50° FOV, pupil-dilated:
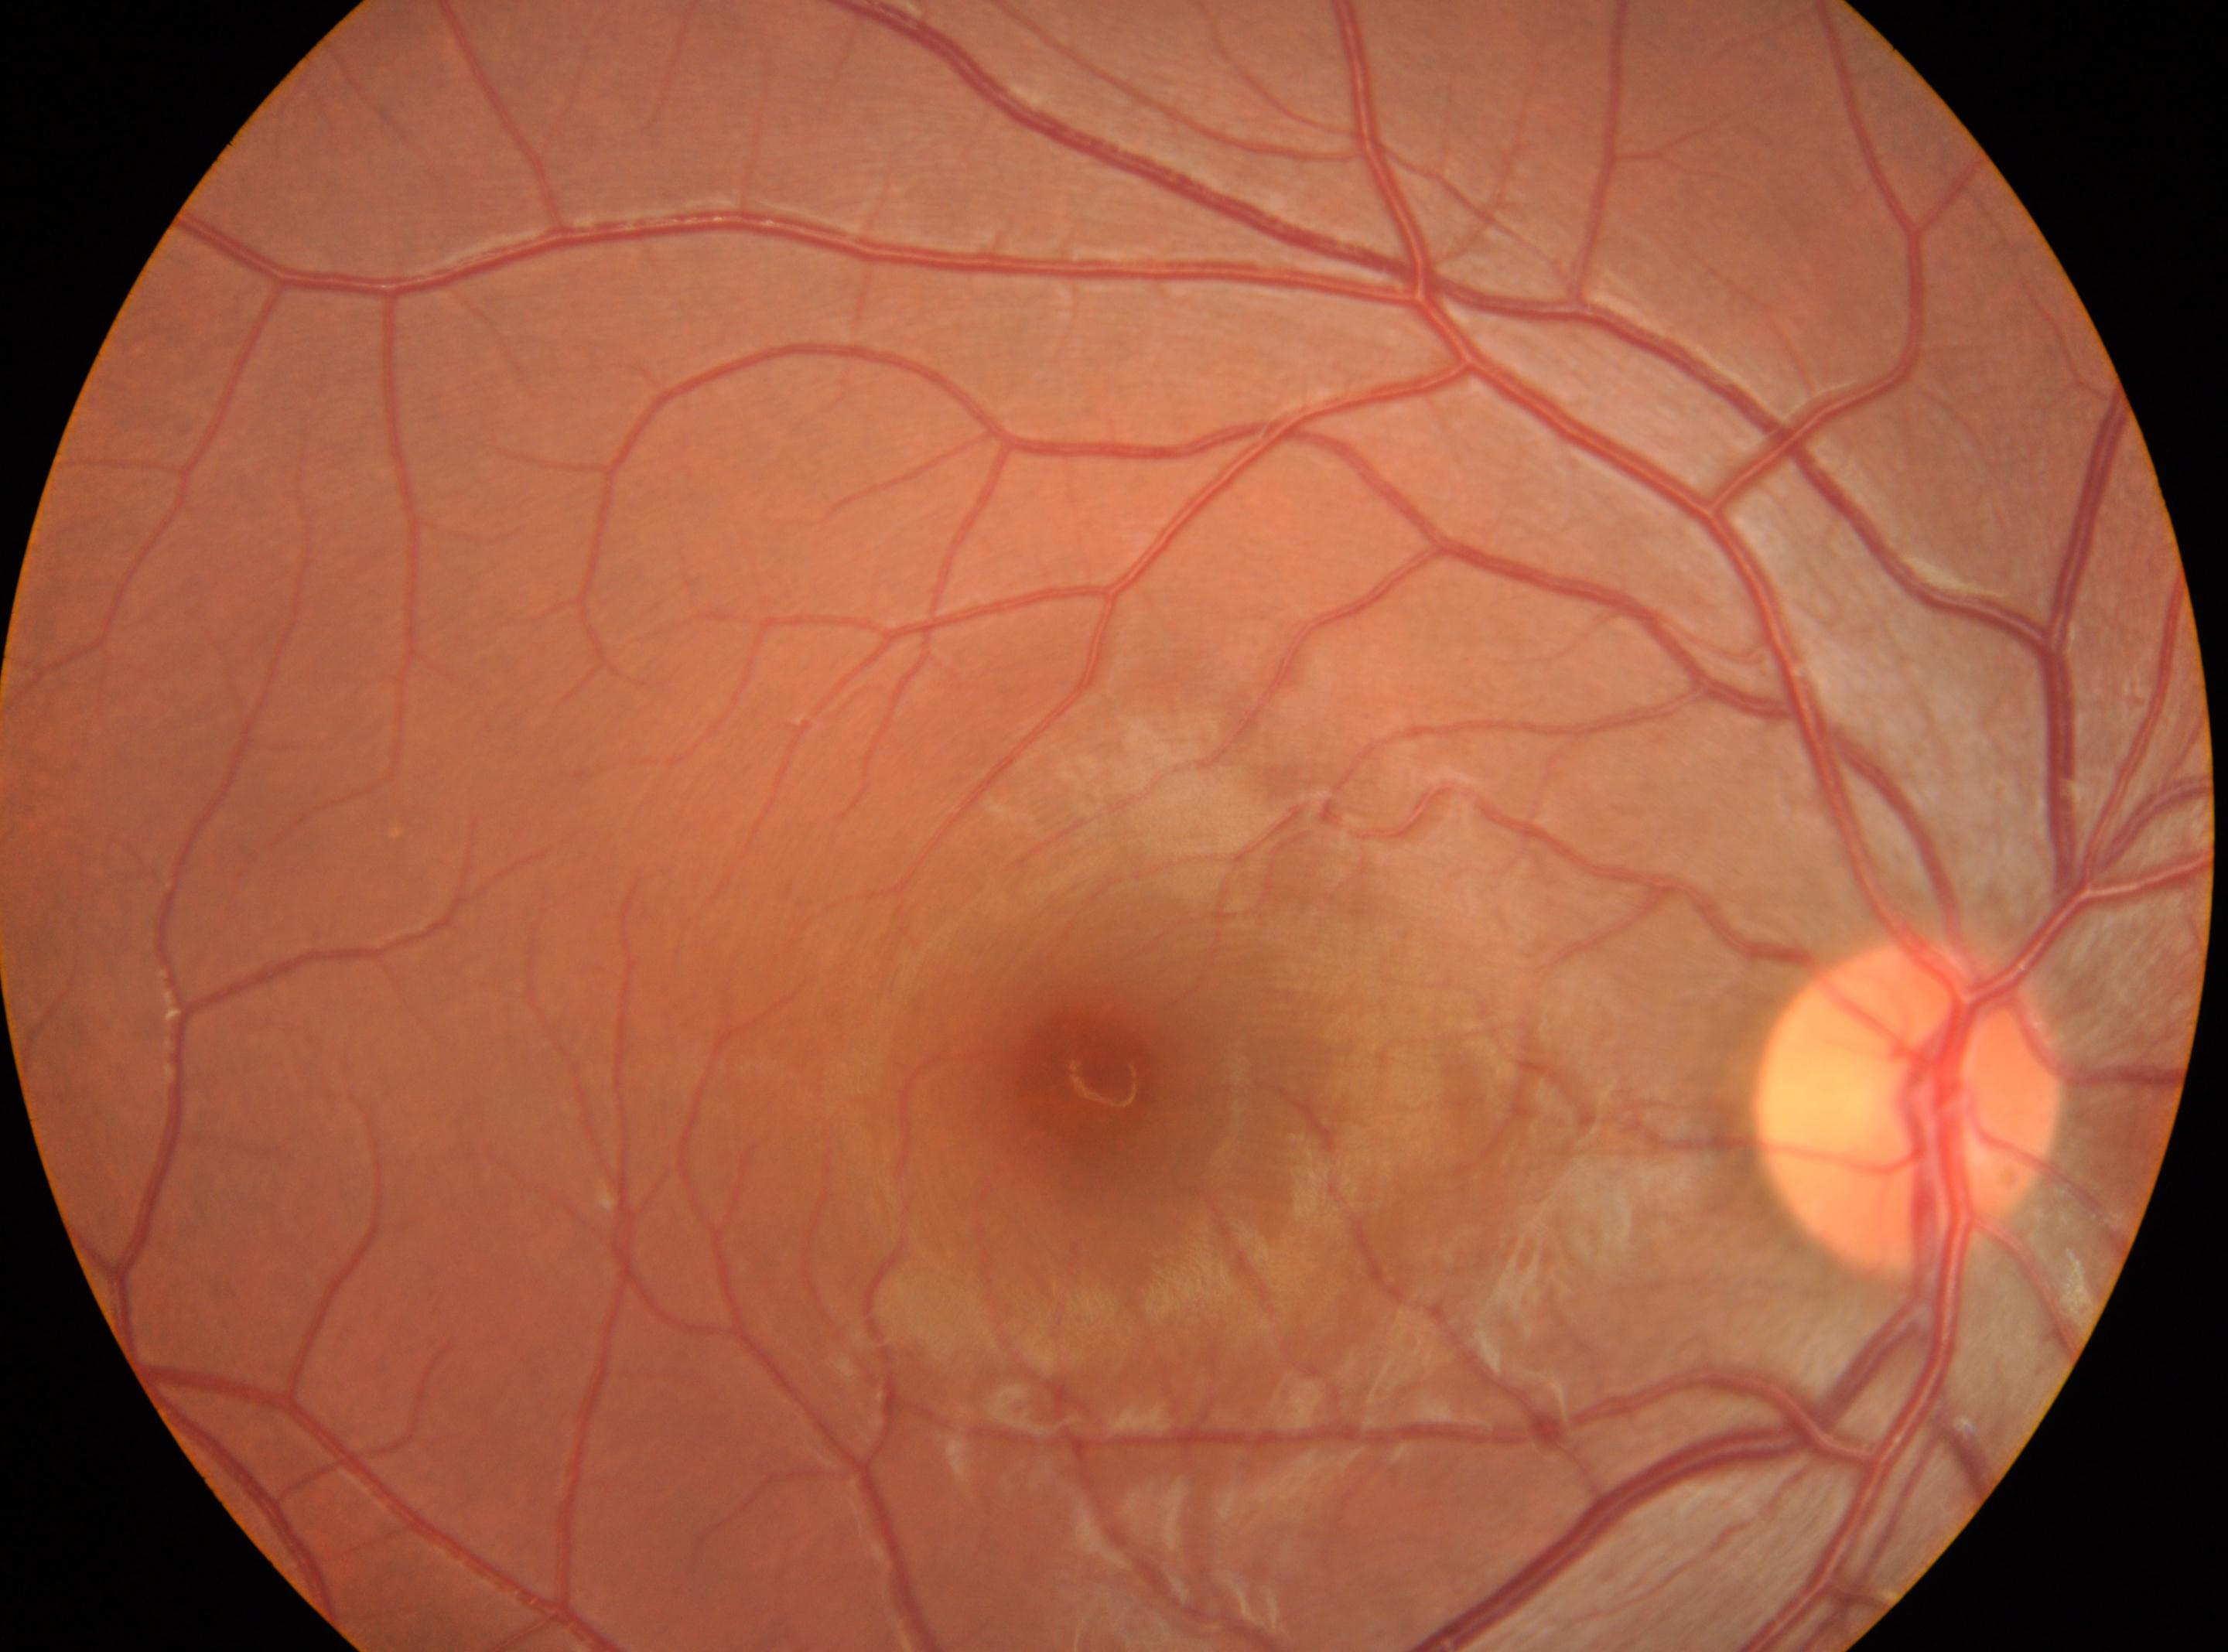 Fovea located at (x=1099, y=1073).
ONH located at (x=1908, y=1108).
Eye: the right eye.
DR severity is grade 0.